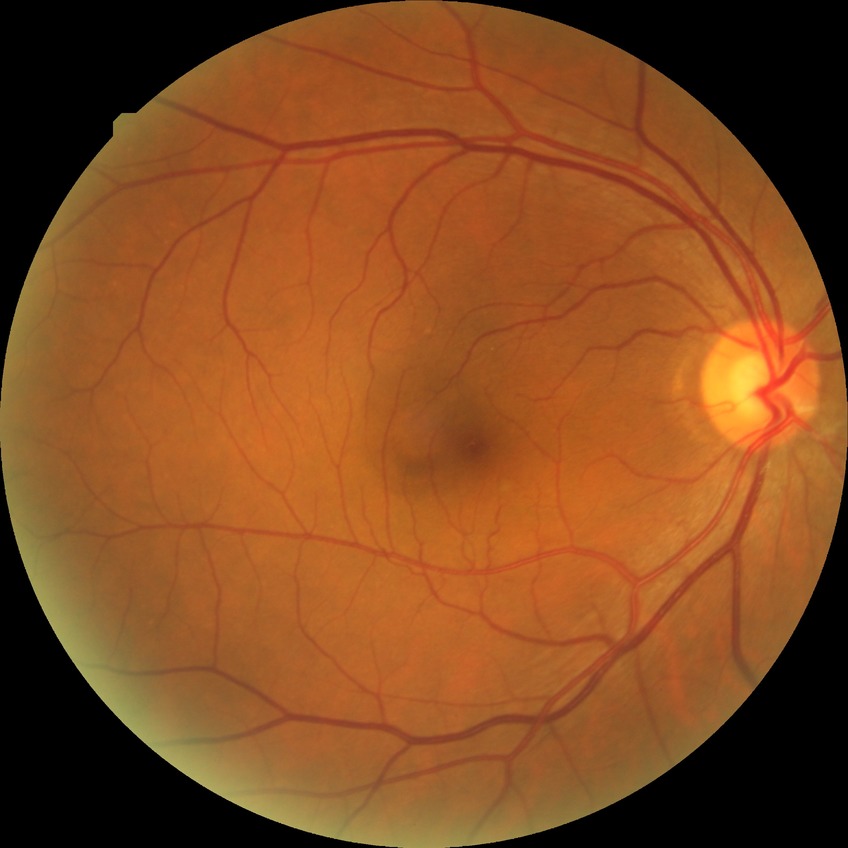

Retinopathy stage is no diabetic retinopathy.